IOP 14 mmHg; FOV: 30 degrees; age 58; sex: F — 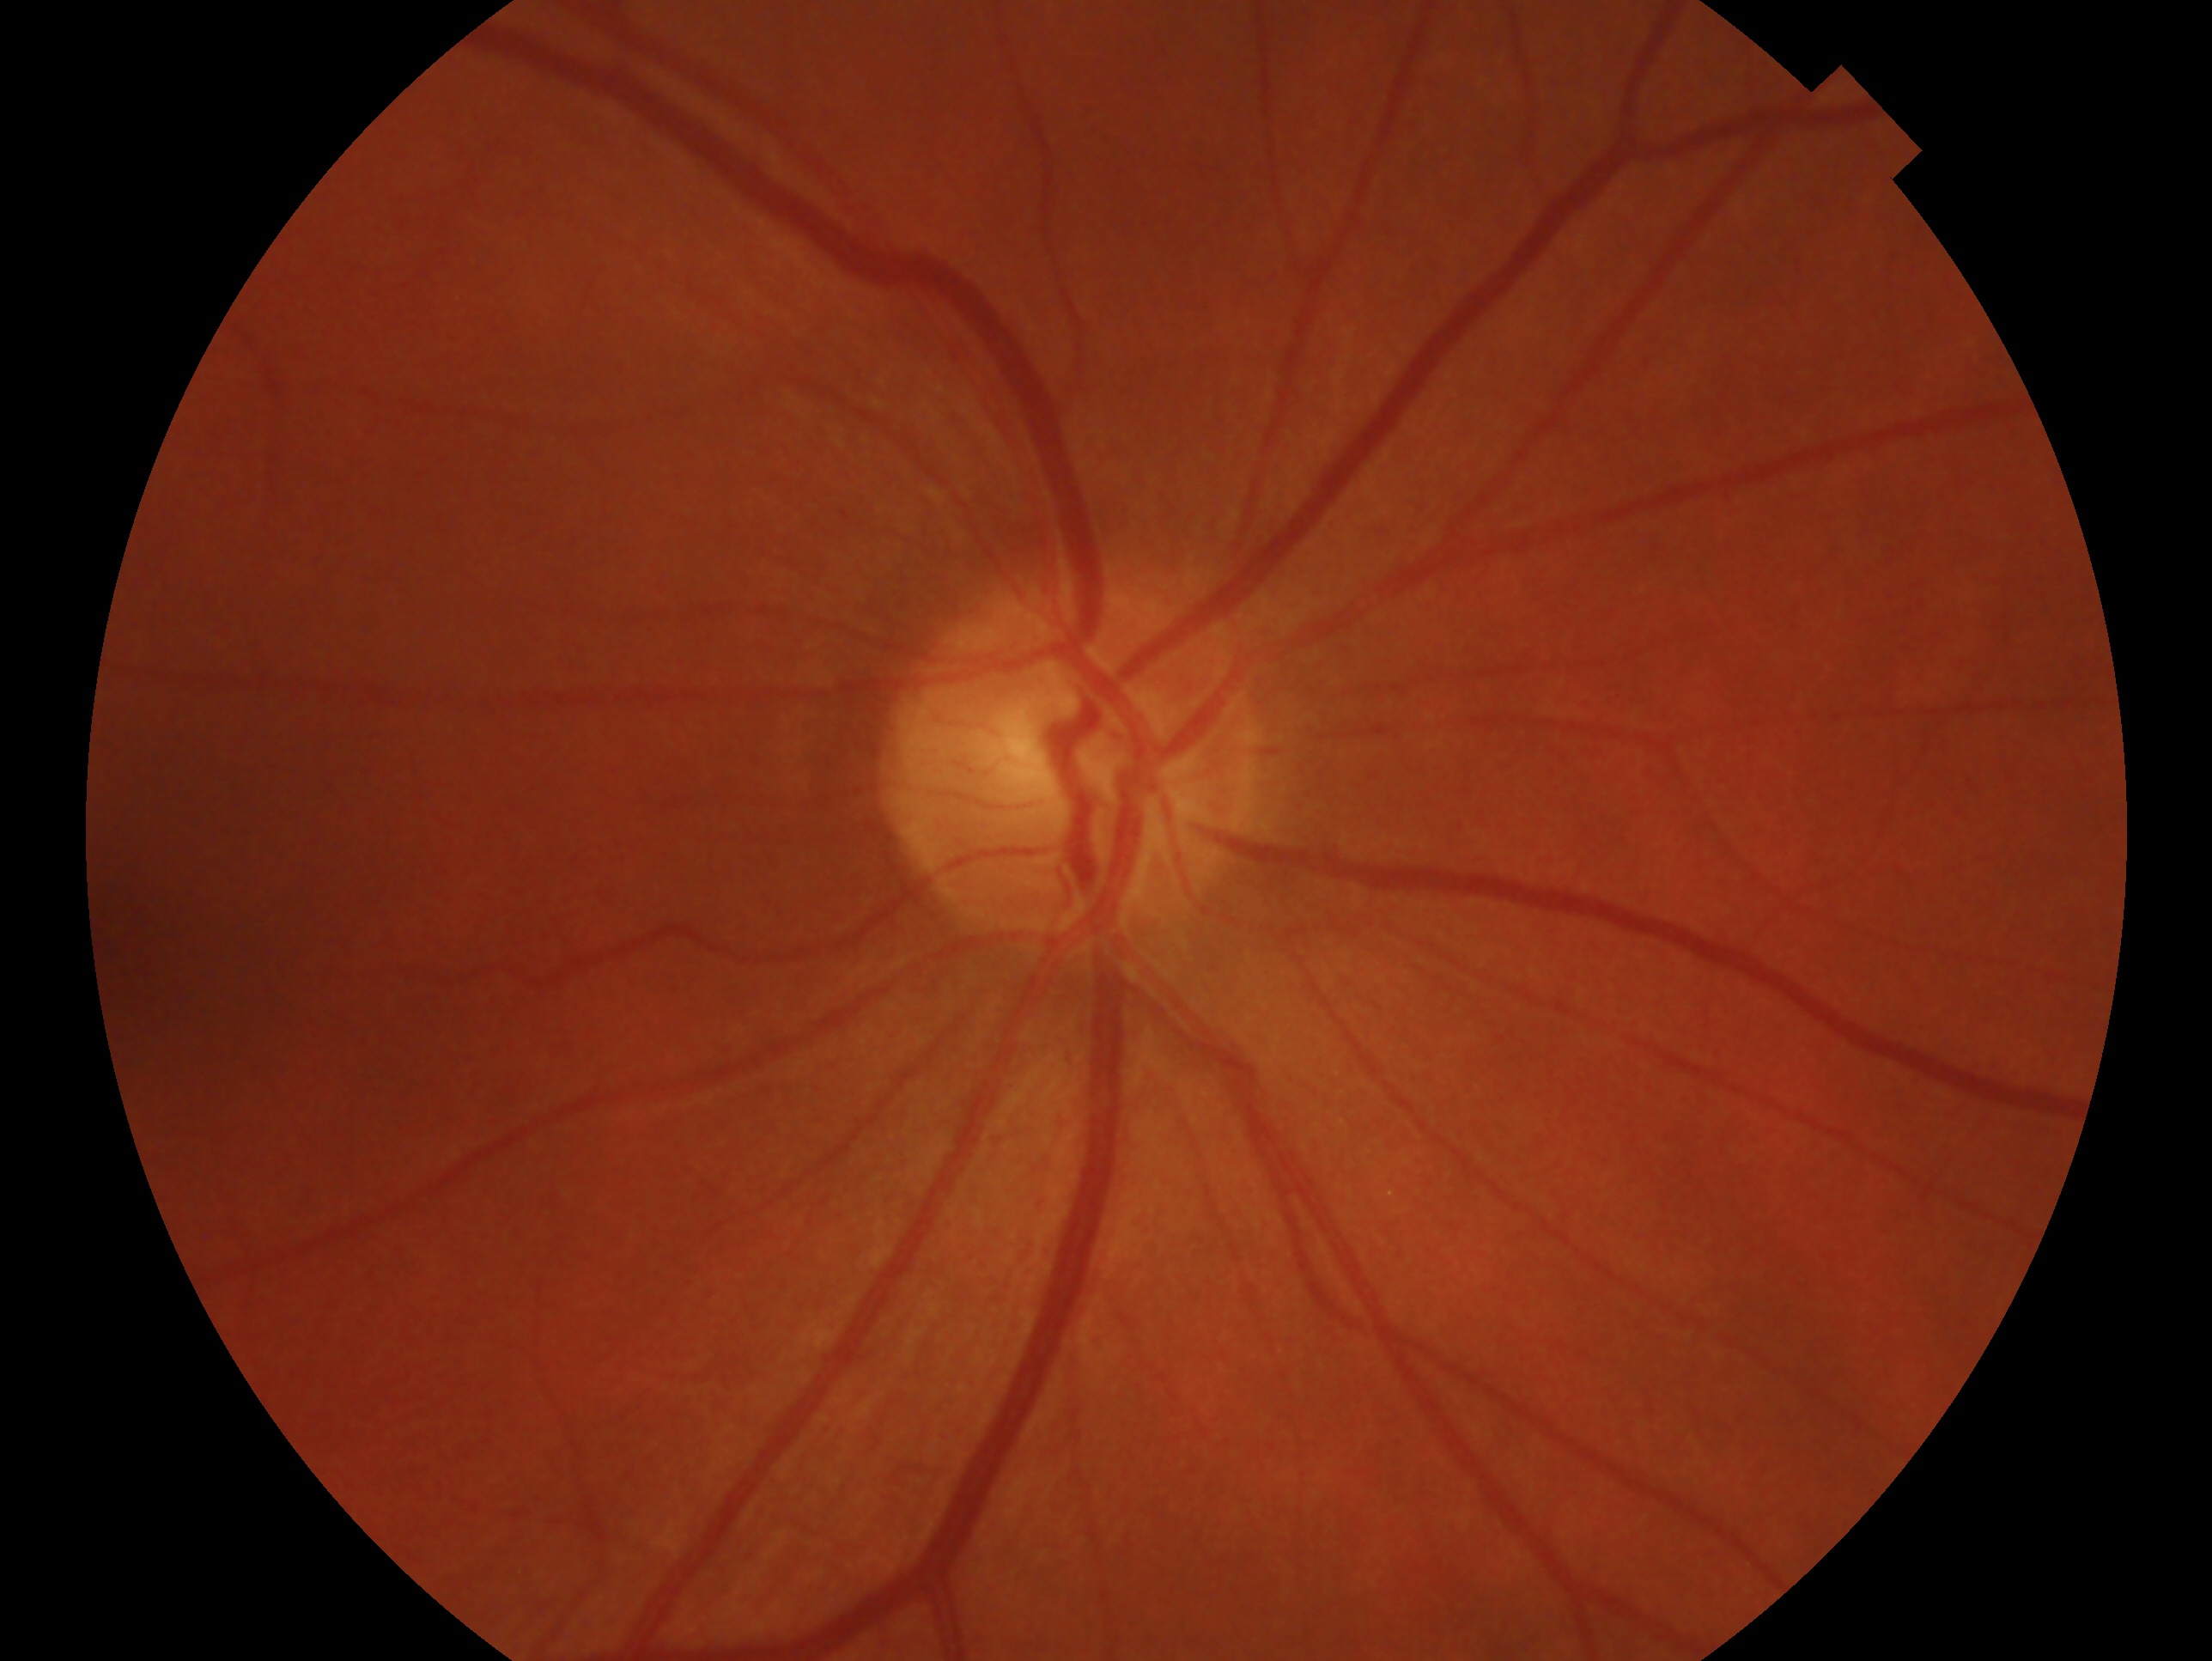
{"glaucoma_dx": "no glaucoma", "eye": "right eye"}